Image size 1240x1240. Acquired on the Phoenix ICON. Wide-field contact fundus photograph of an infant
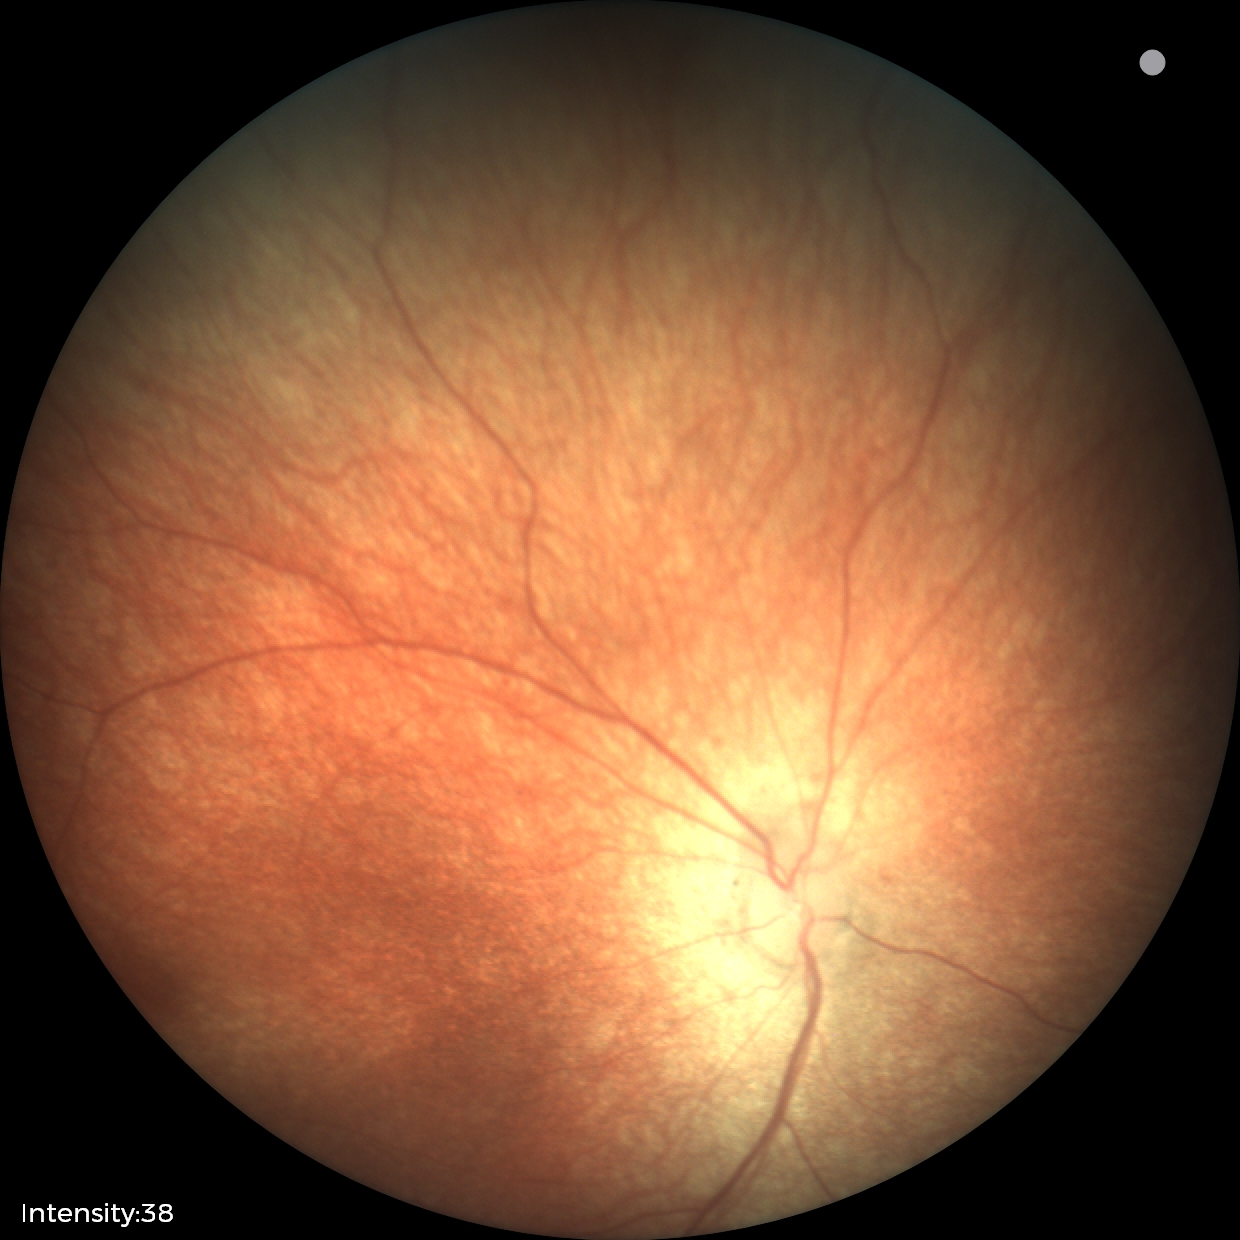

Screening examination diagnosed as physiological.